2346 x 1568 pixels: 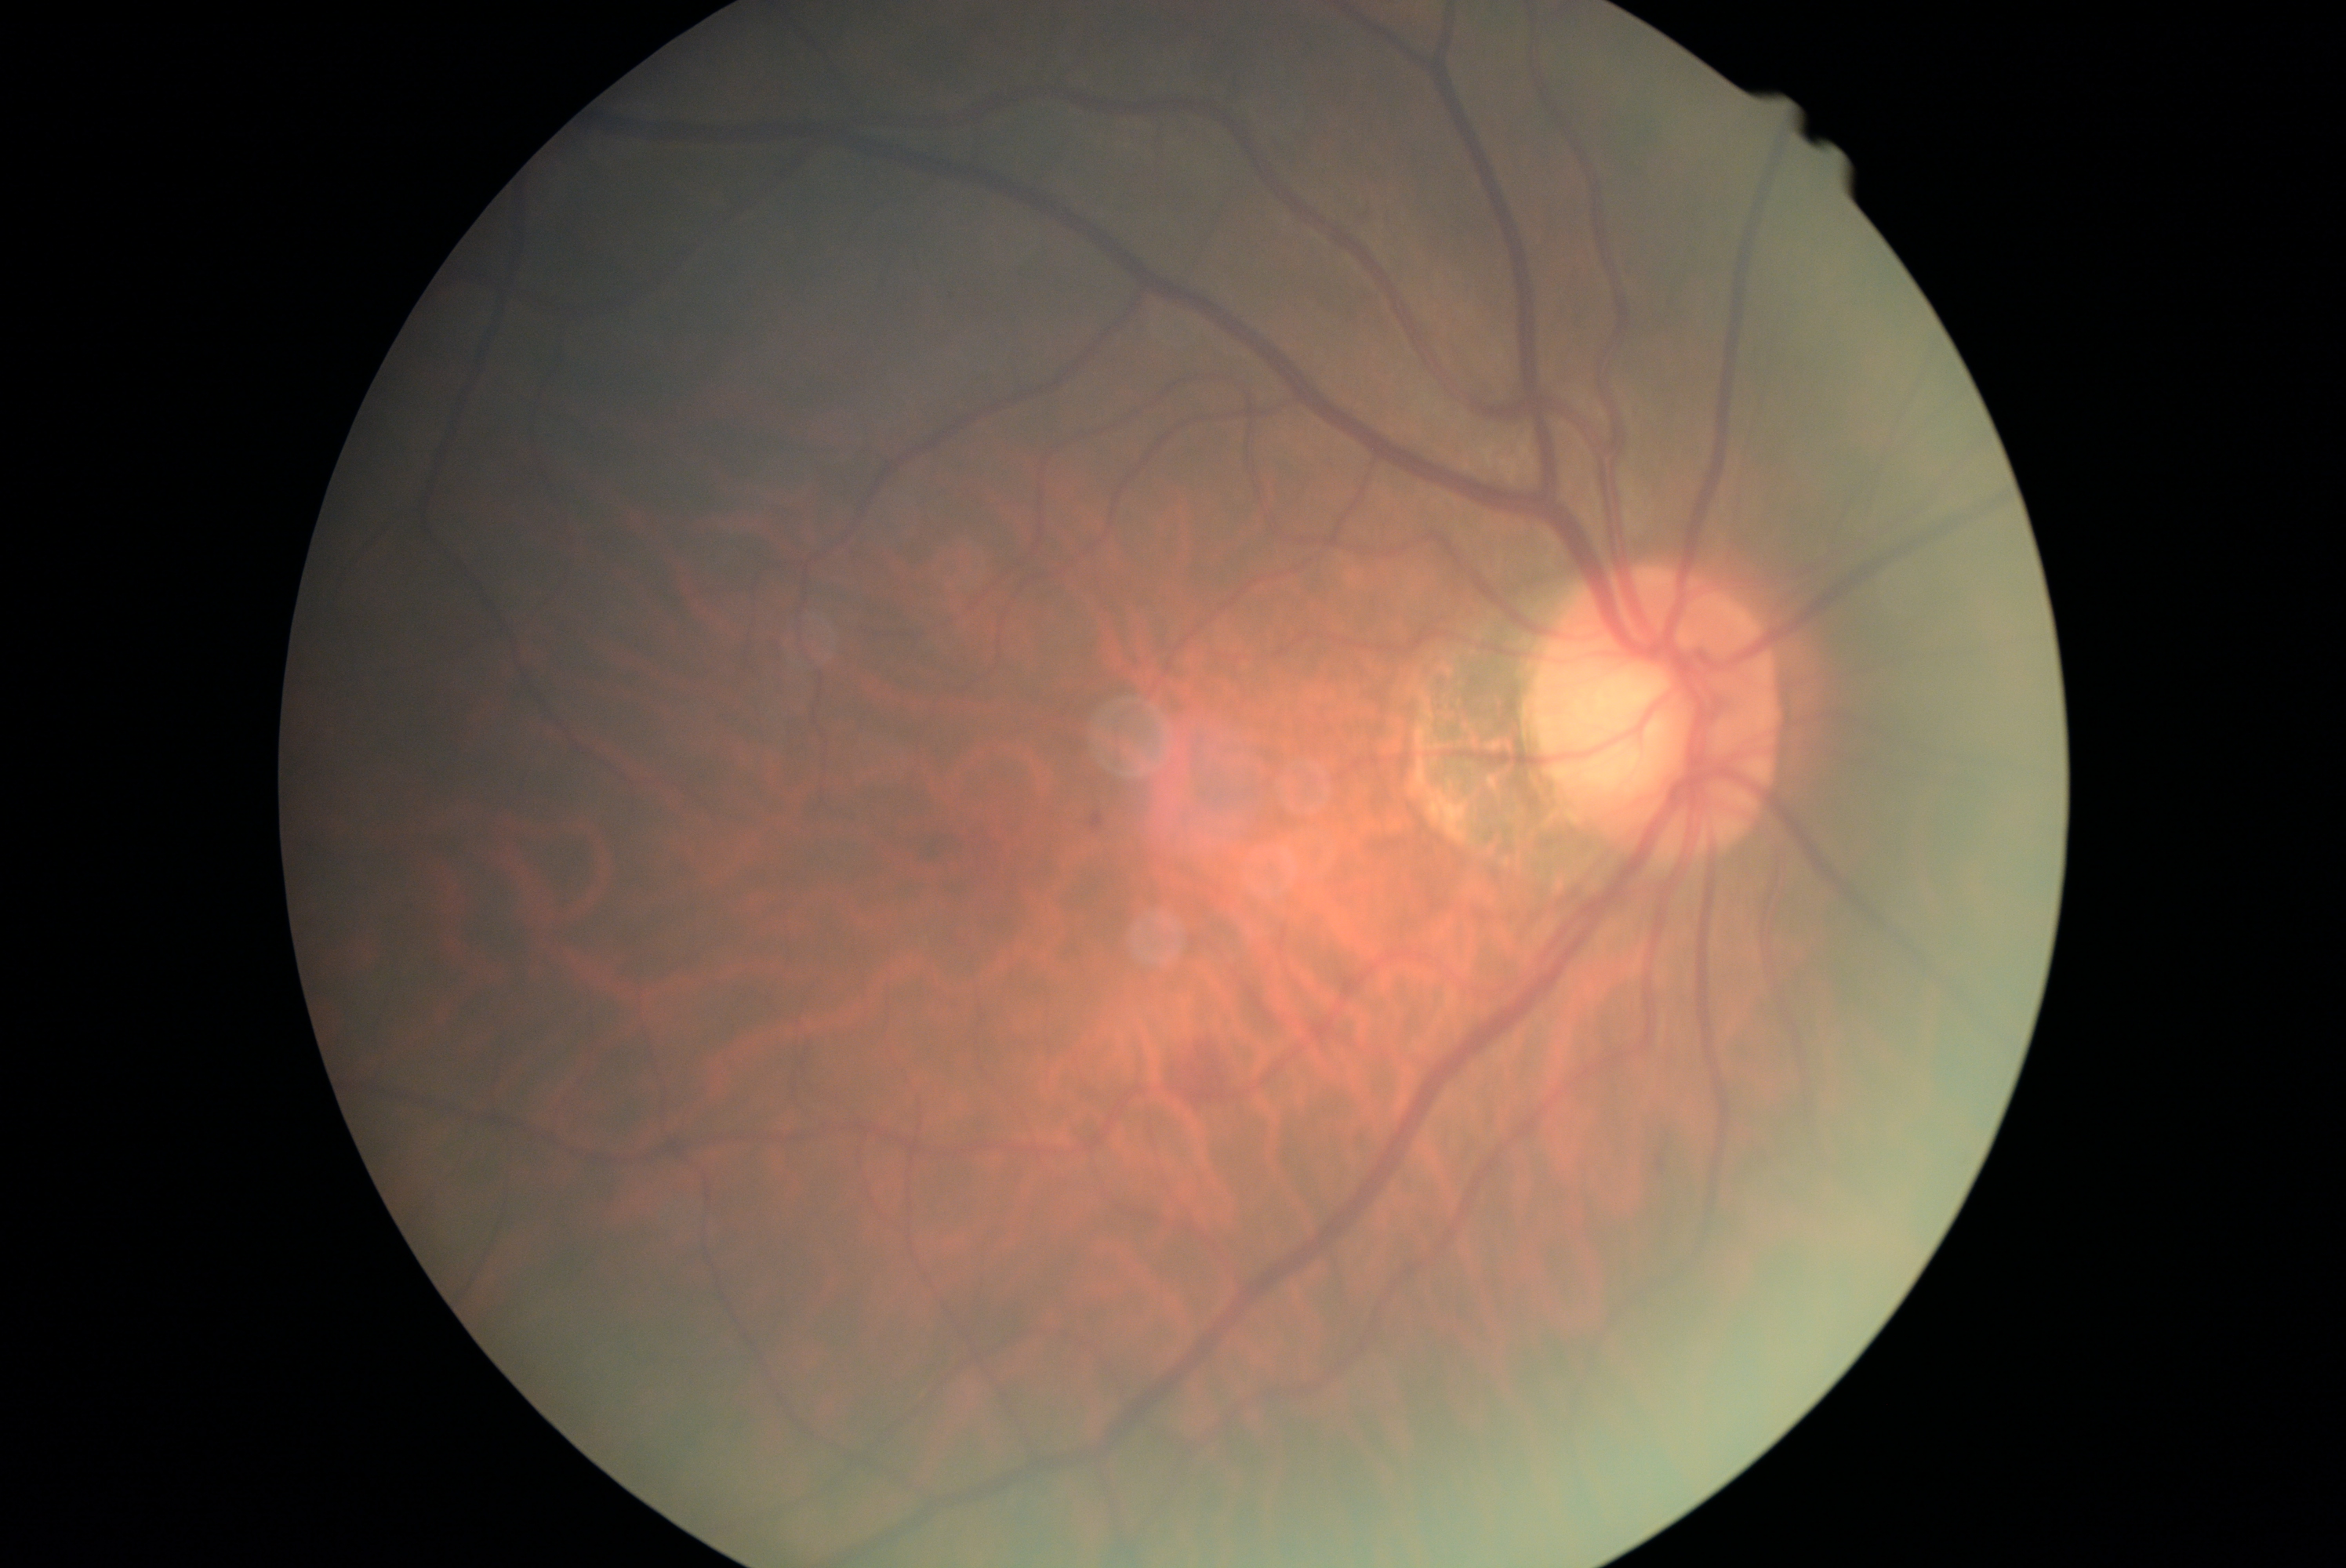
Diabetic retinopathy severity is grade 2 (moderate NPDR).
The retinopathy is classified as non-proliferative diabetic retinopathy.